200-degree field of view. Ultra-widefield (UWF) fundus image:
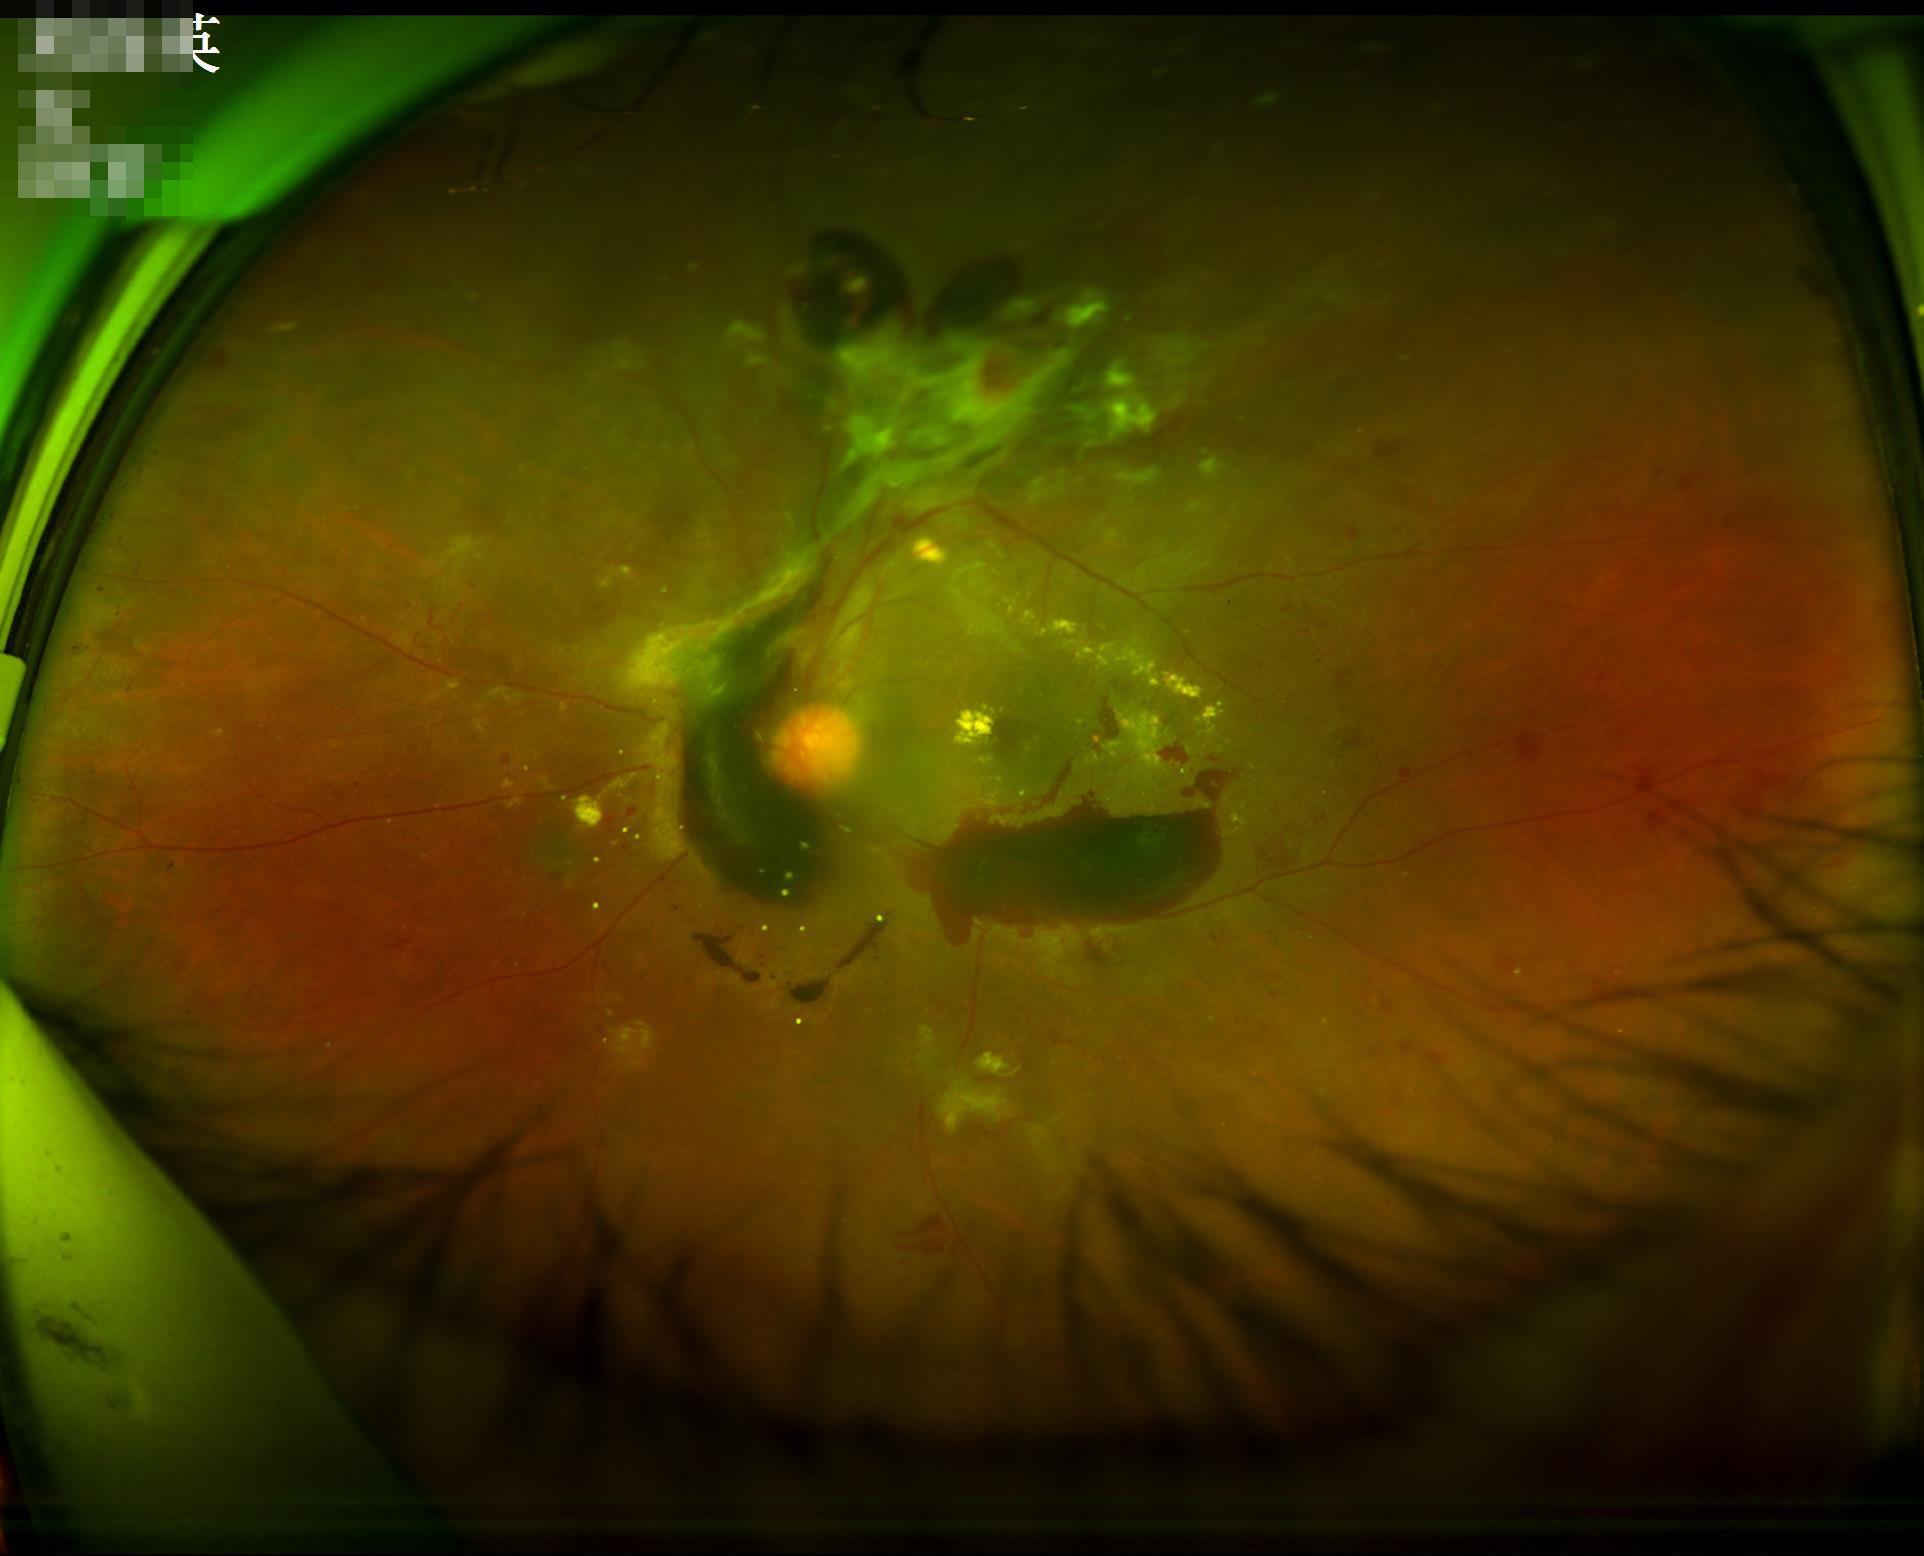 The image is blurry. Poor illumination with uneven exposure. Image quality is inadequate for diagnostic use.